Infant wide-field fundus photograph · acquired on the Phoenix ICON: 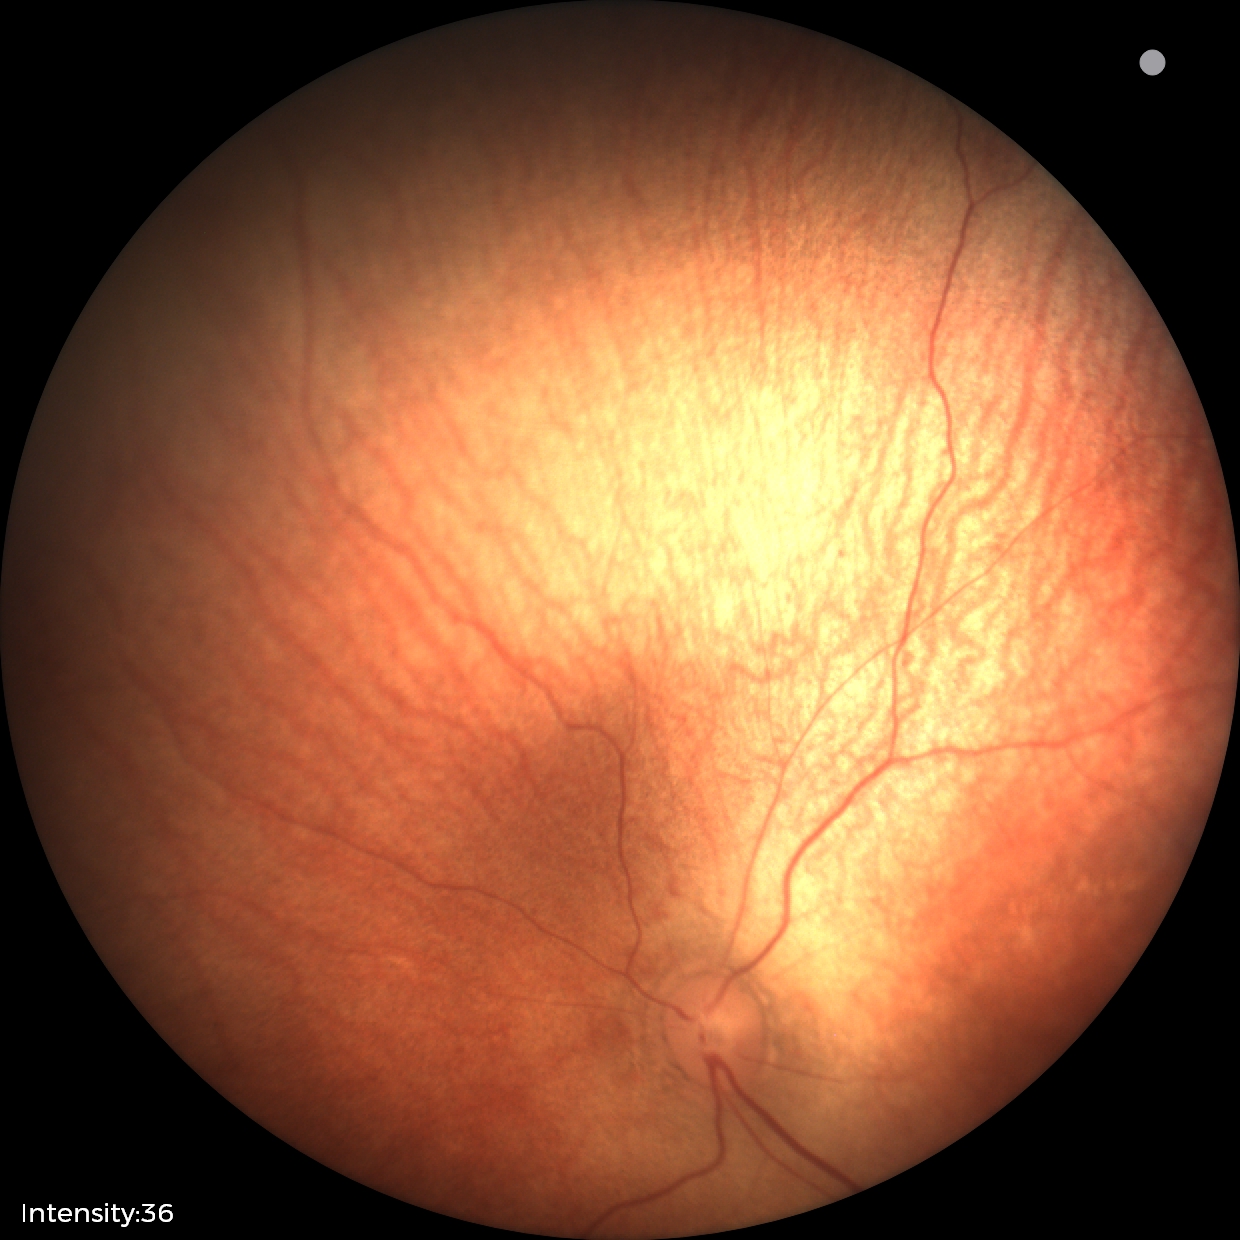

Screening: physiological retinal finding.